Camera: Phoenix ICON (100° FOV) · Phoenix ICON wide-field infant fundus image:
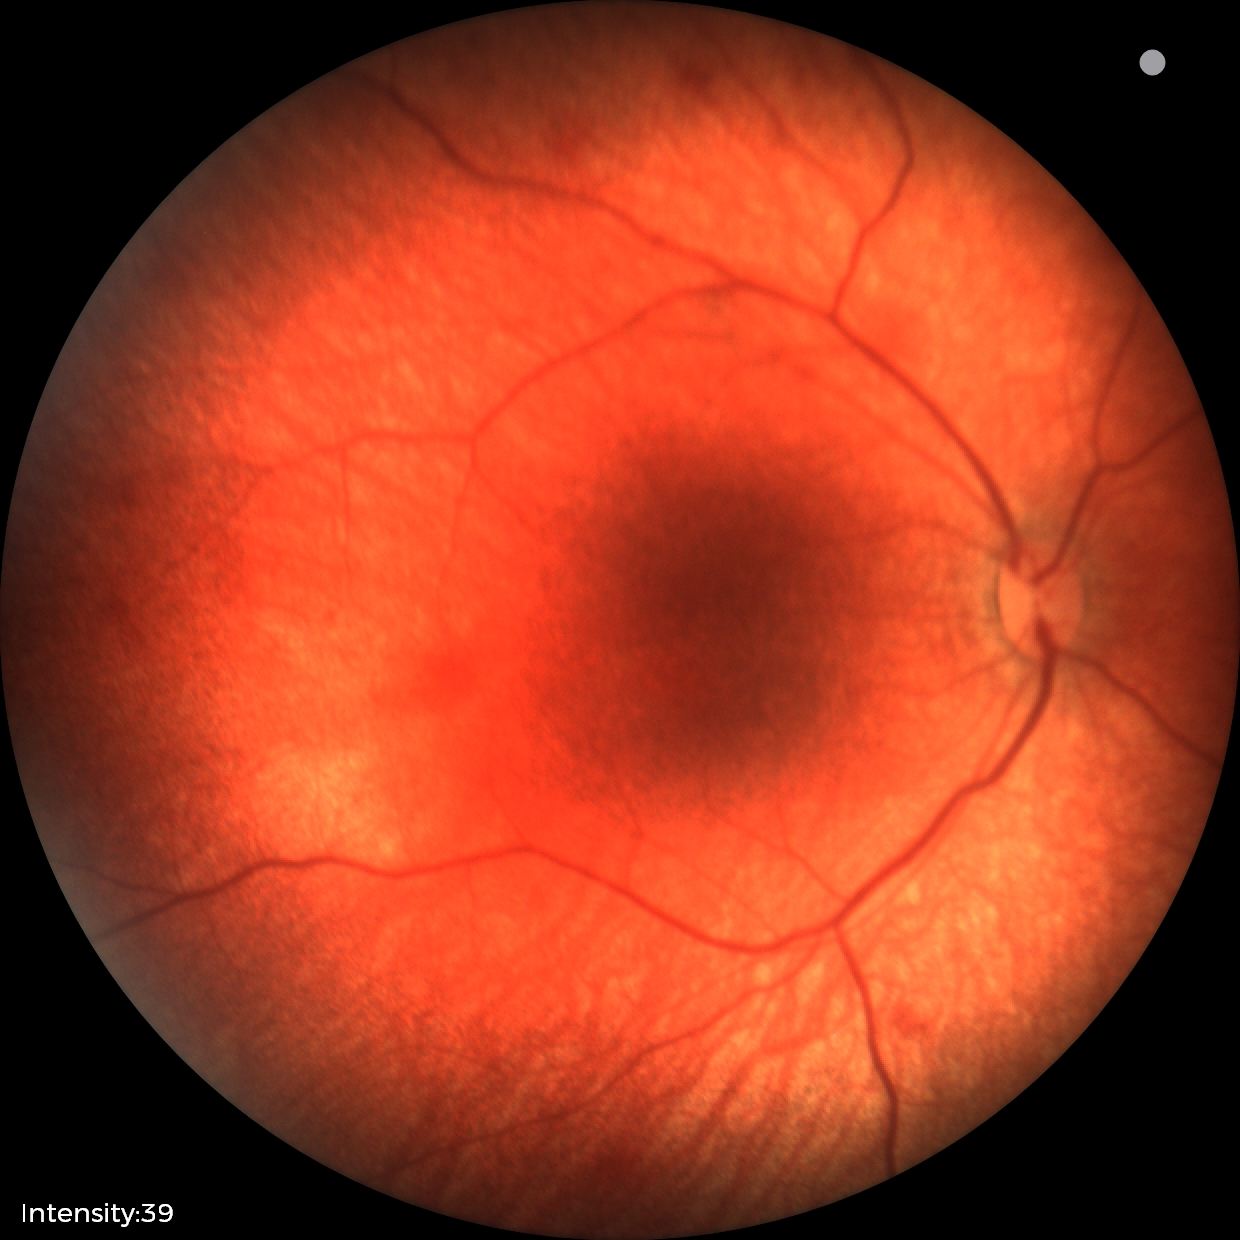 From an examination with diagnosis of retinal hemorrhages.